Color fundus photograph: 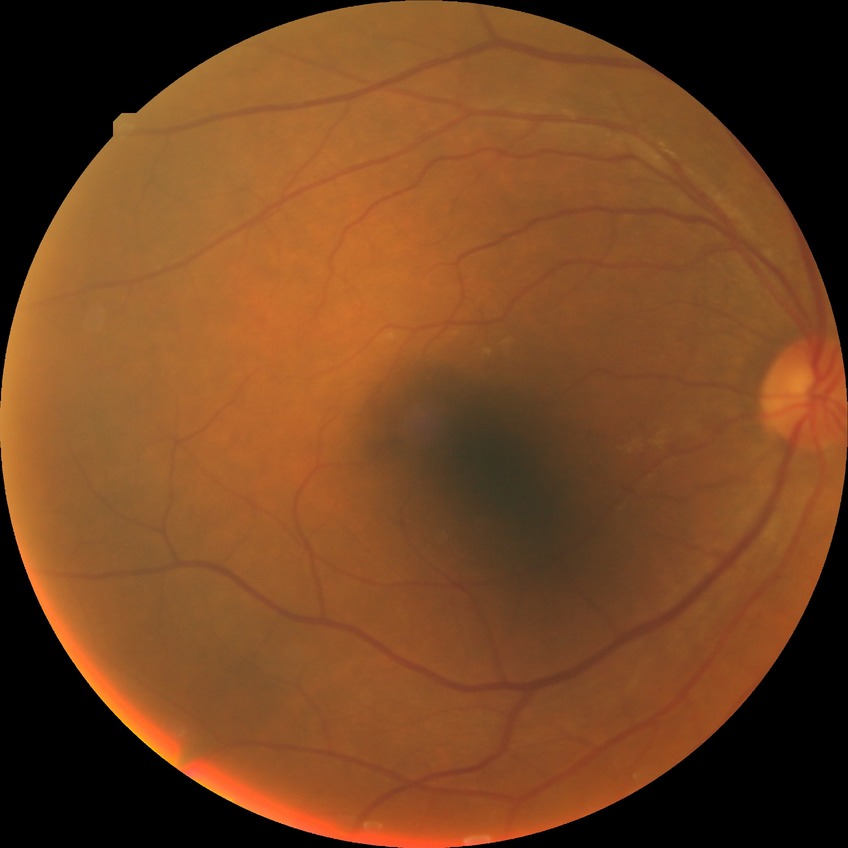

retinopathy grade = pre-proliferative diabetic retinopathy.